Camera: Remidio FOP fundus camera — 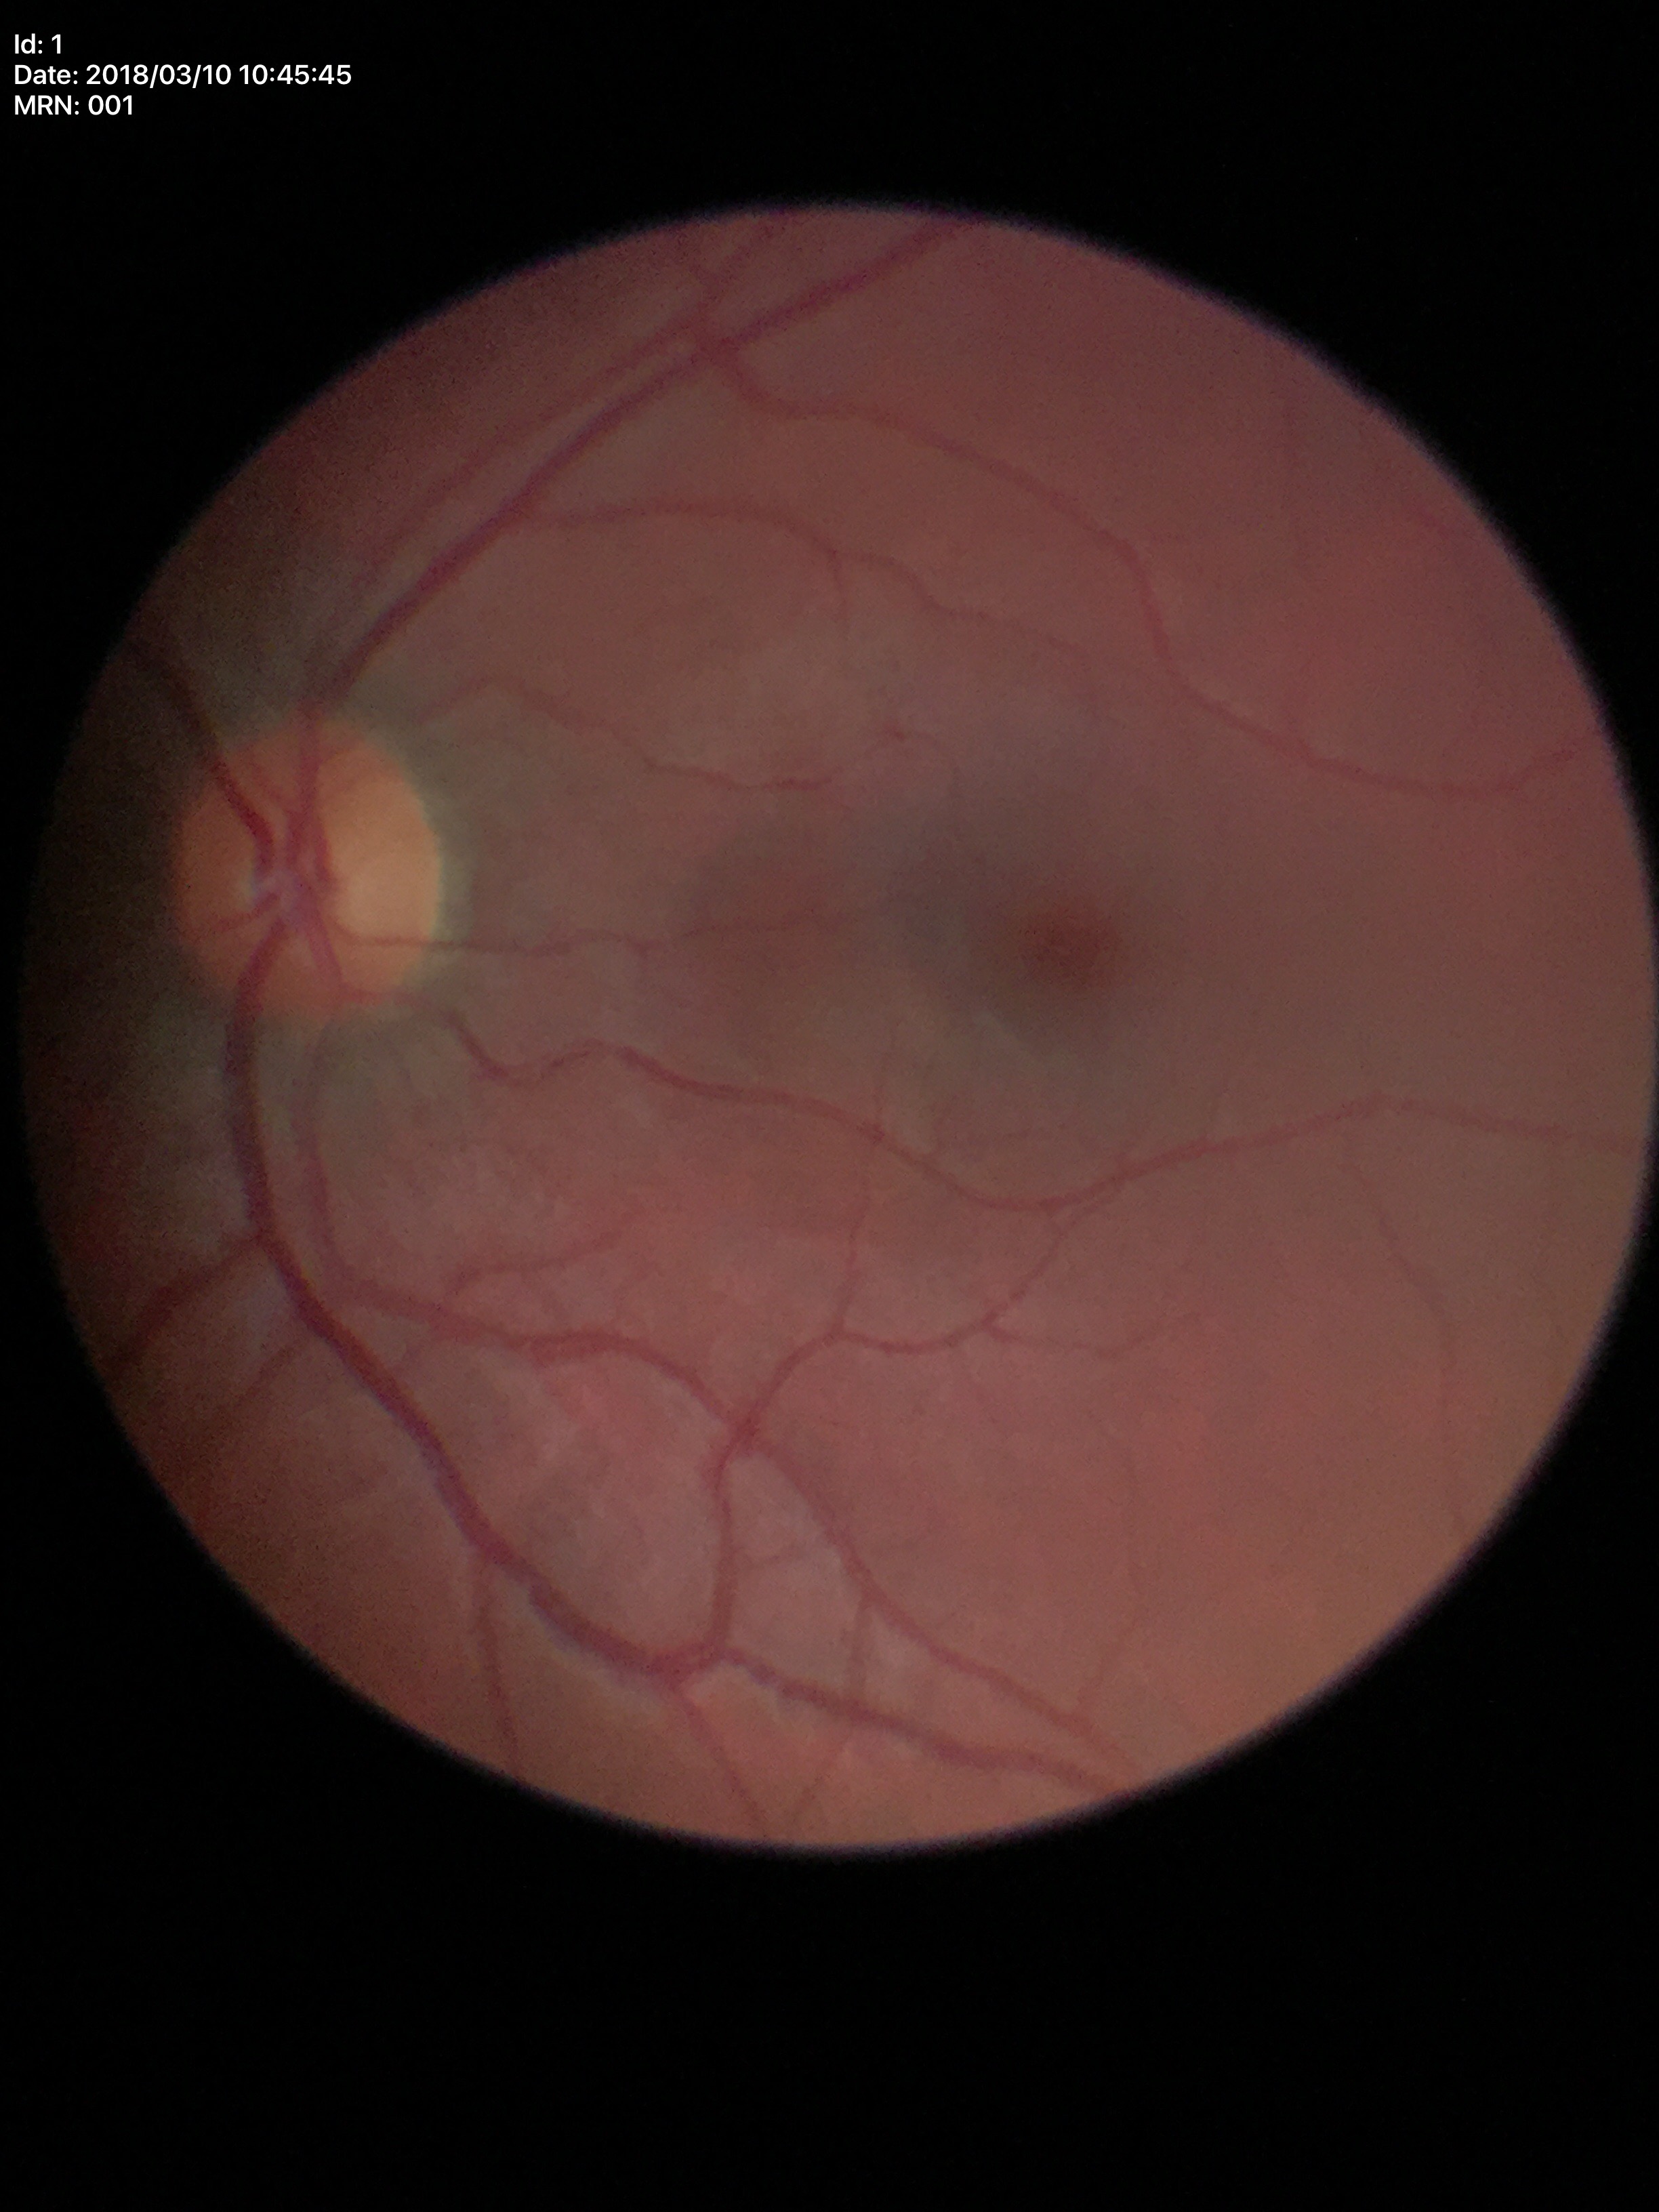
Glaucoma evaluation: not suspect; VCDR: 0.45; HCDR: 0.46